Retinal fundus photograph. 1380 by 1382 pixels — 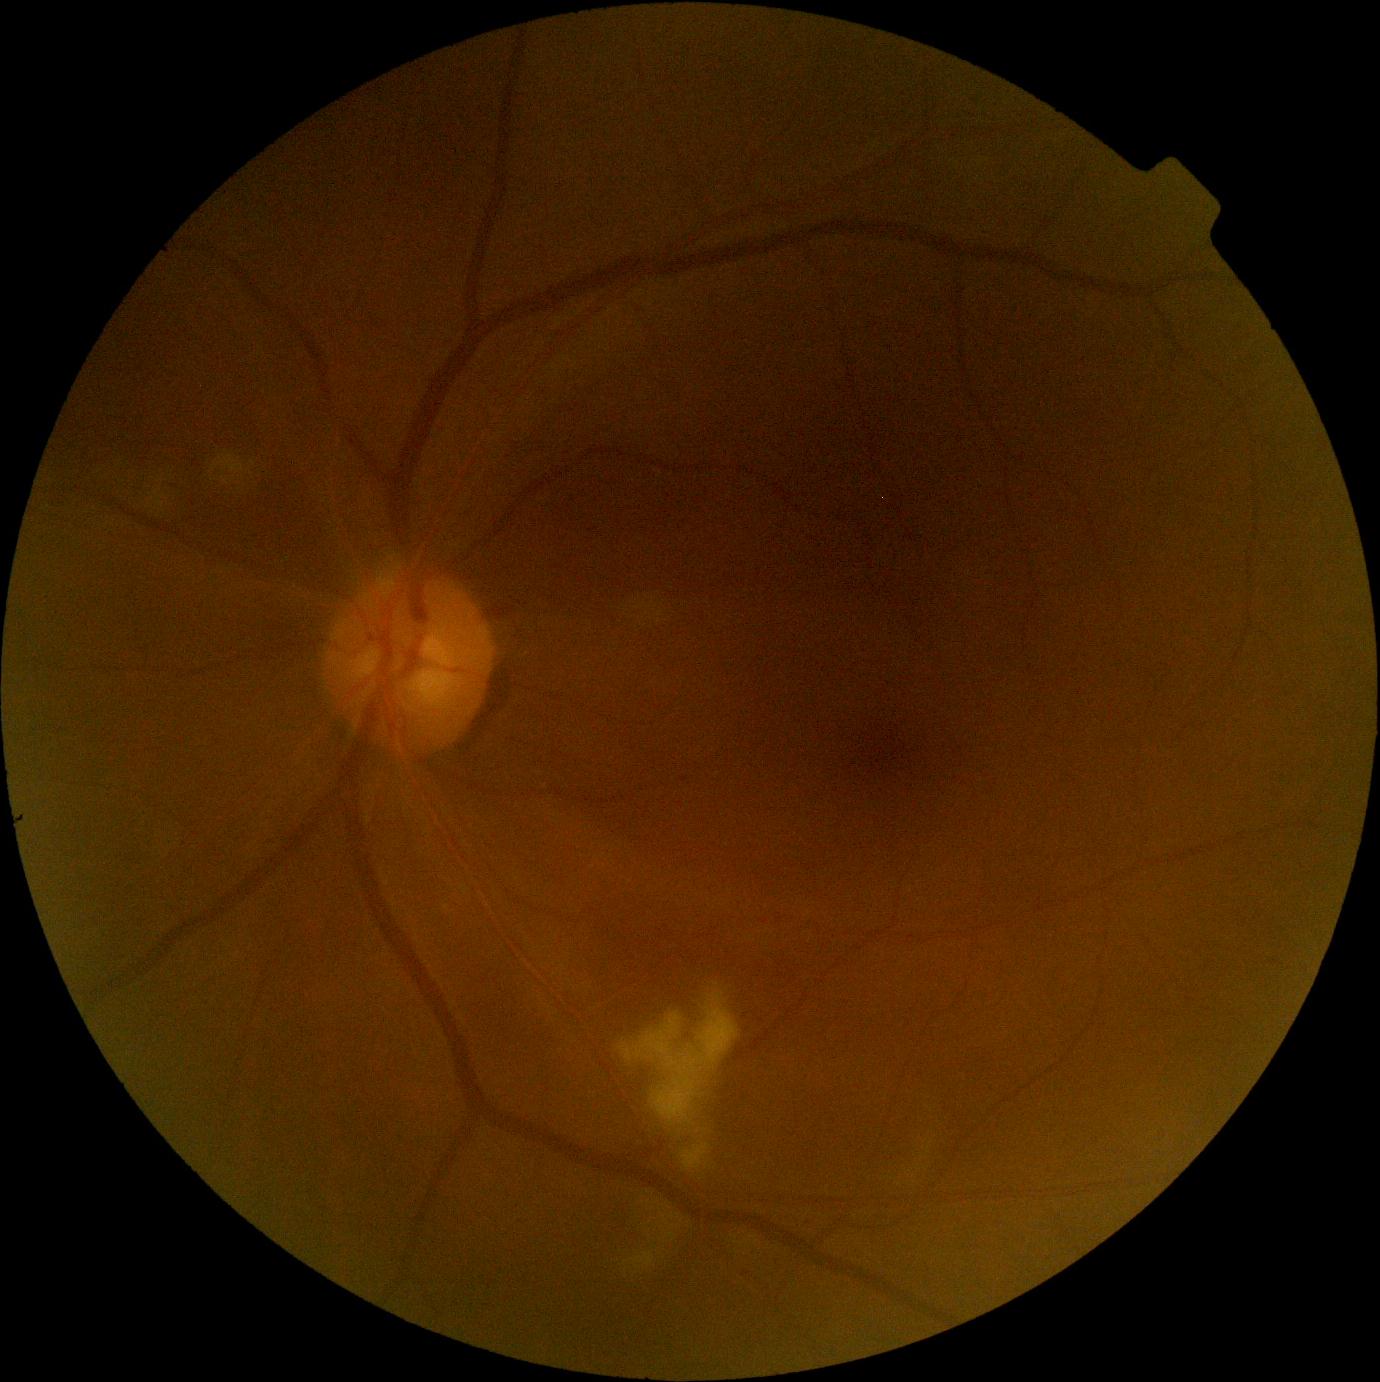 {
  "dr_grade": "grade 2"
}